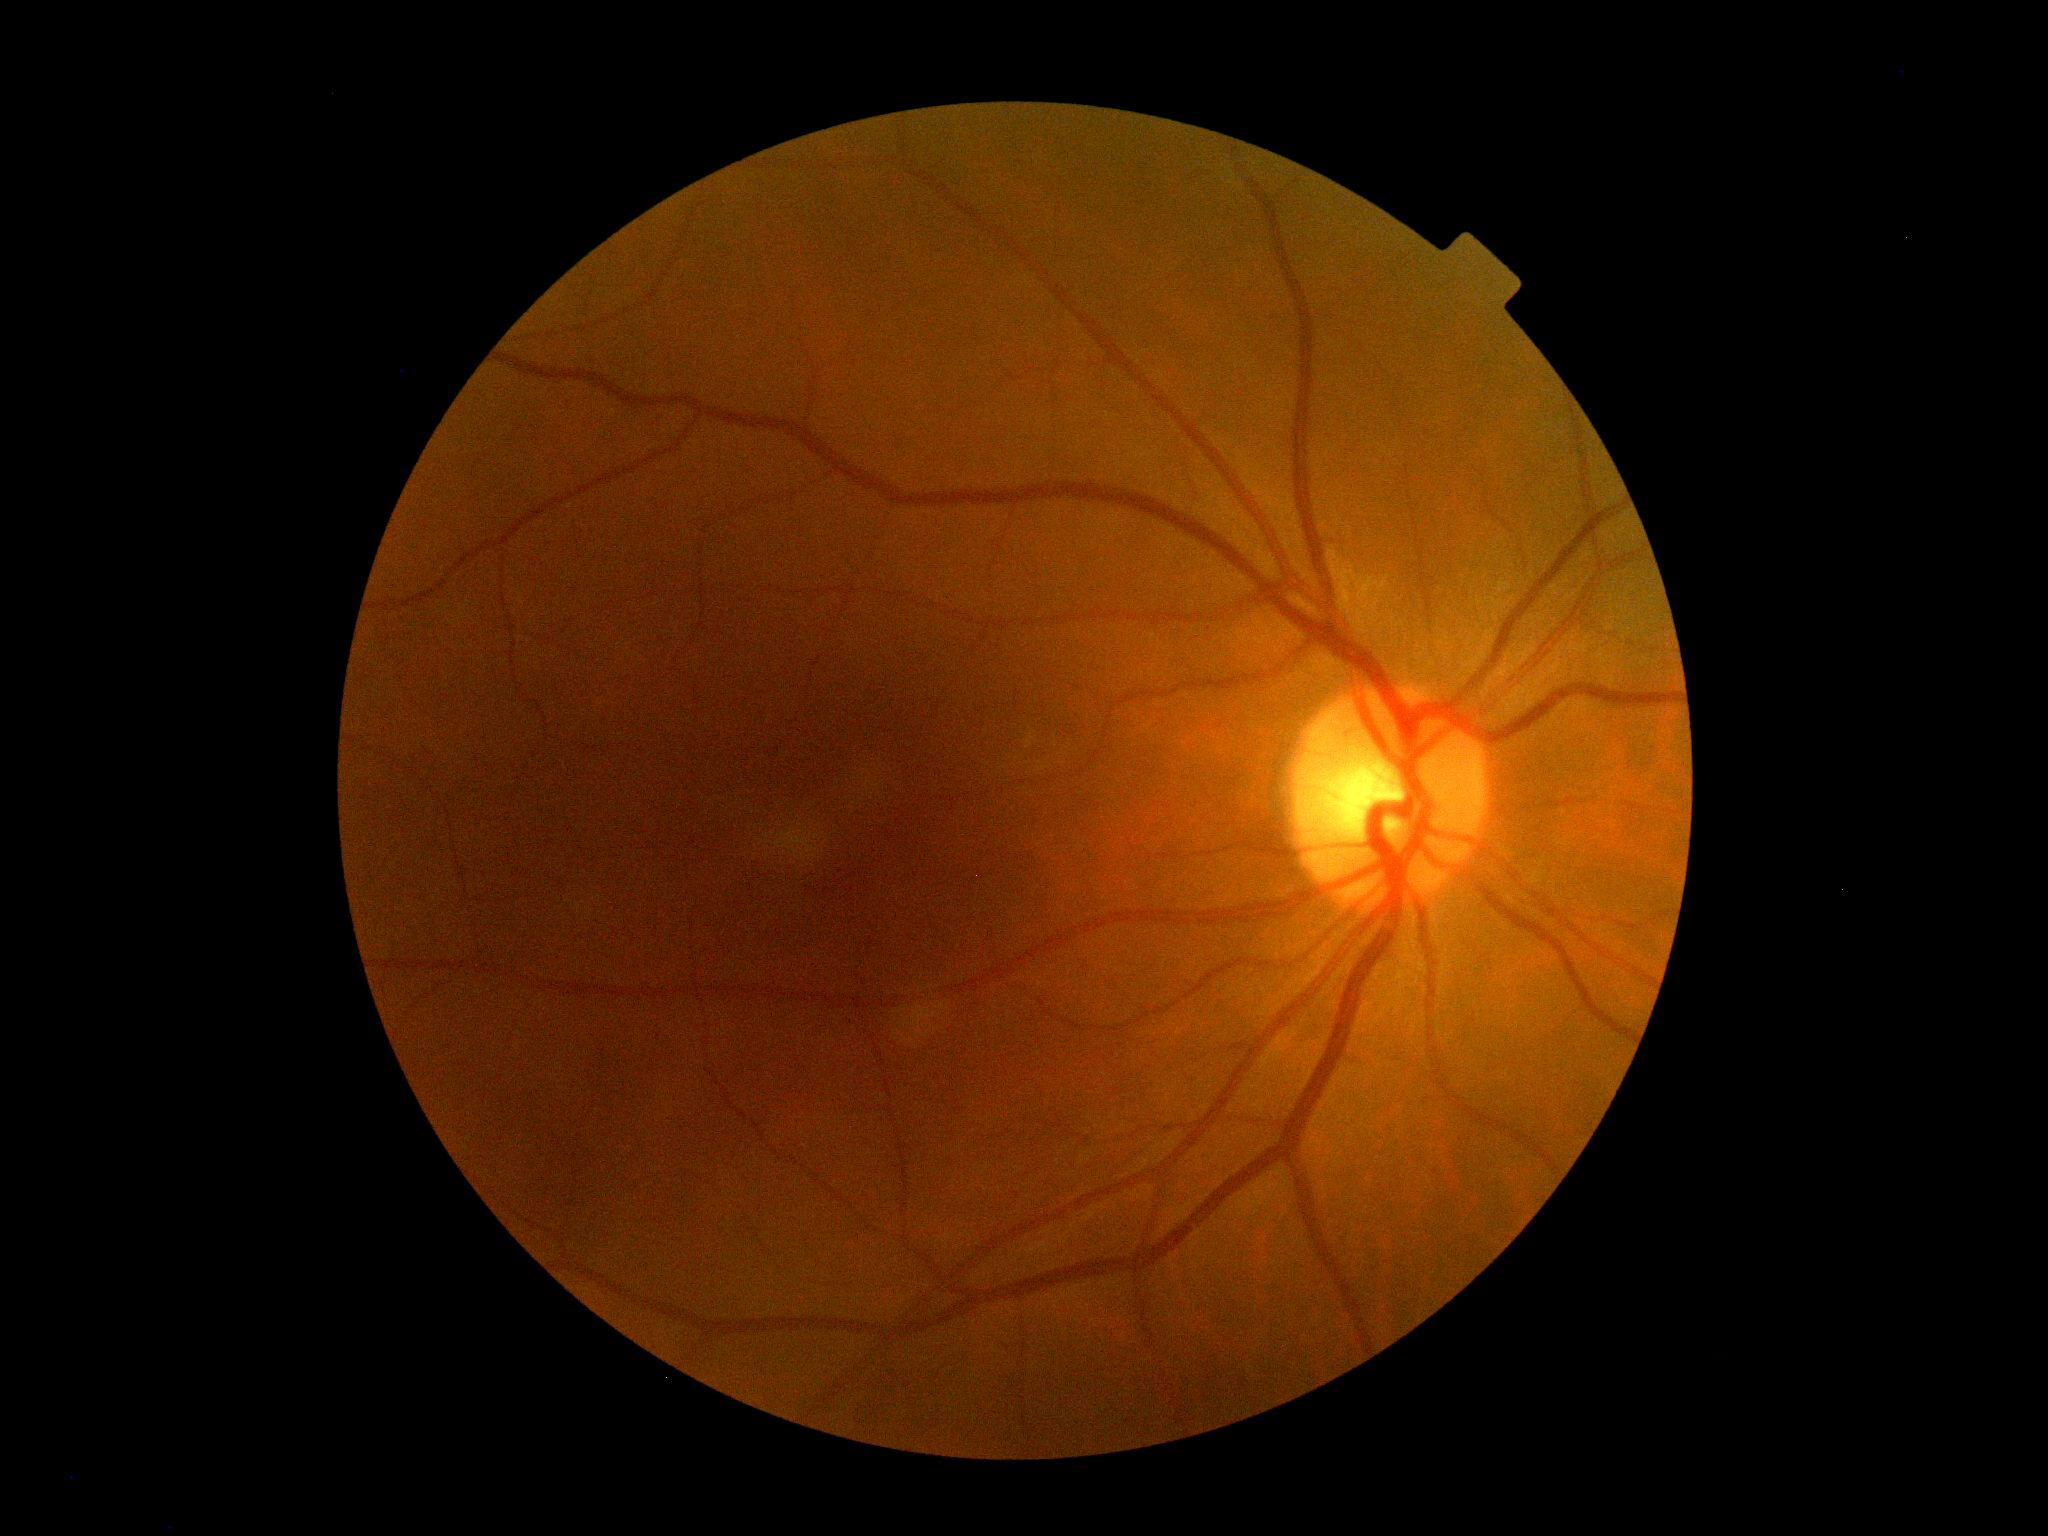

DR severity: grade 0 (no apparent retinopathy).